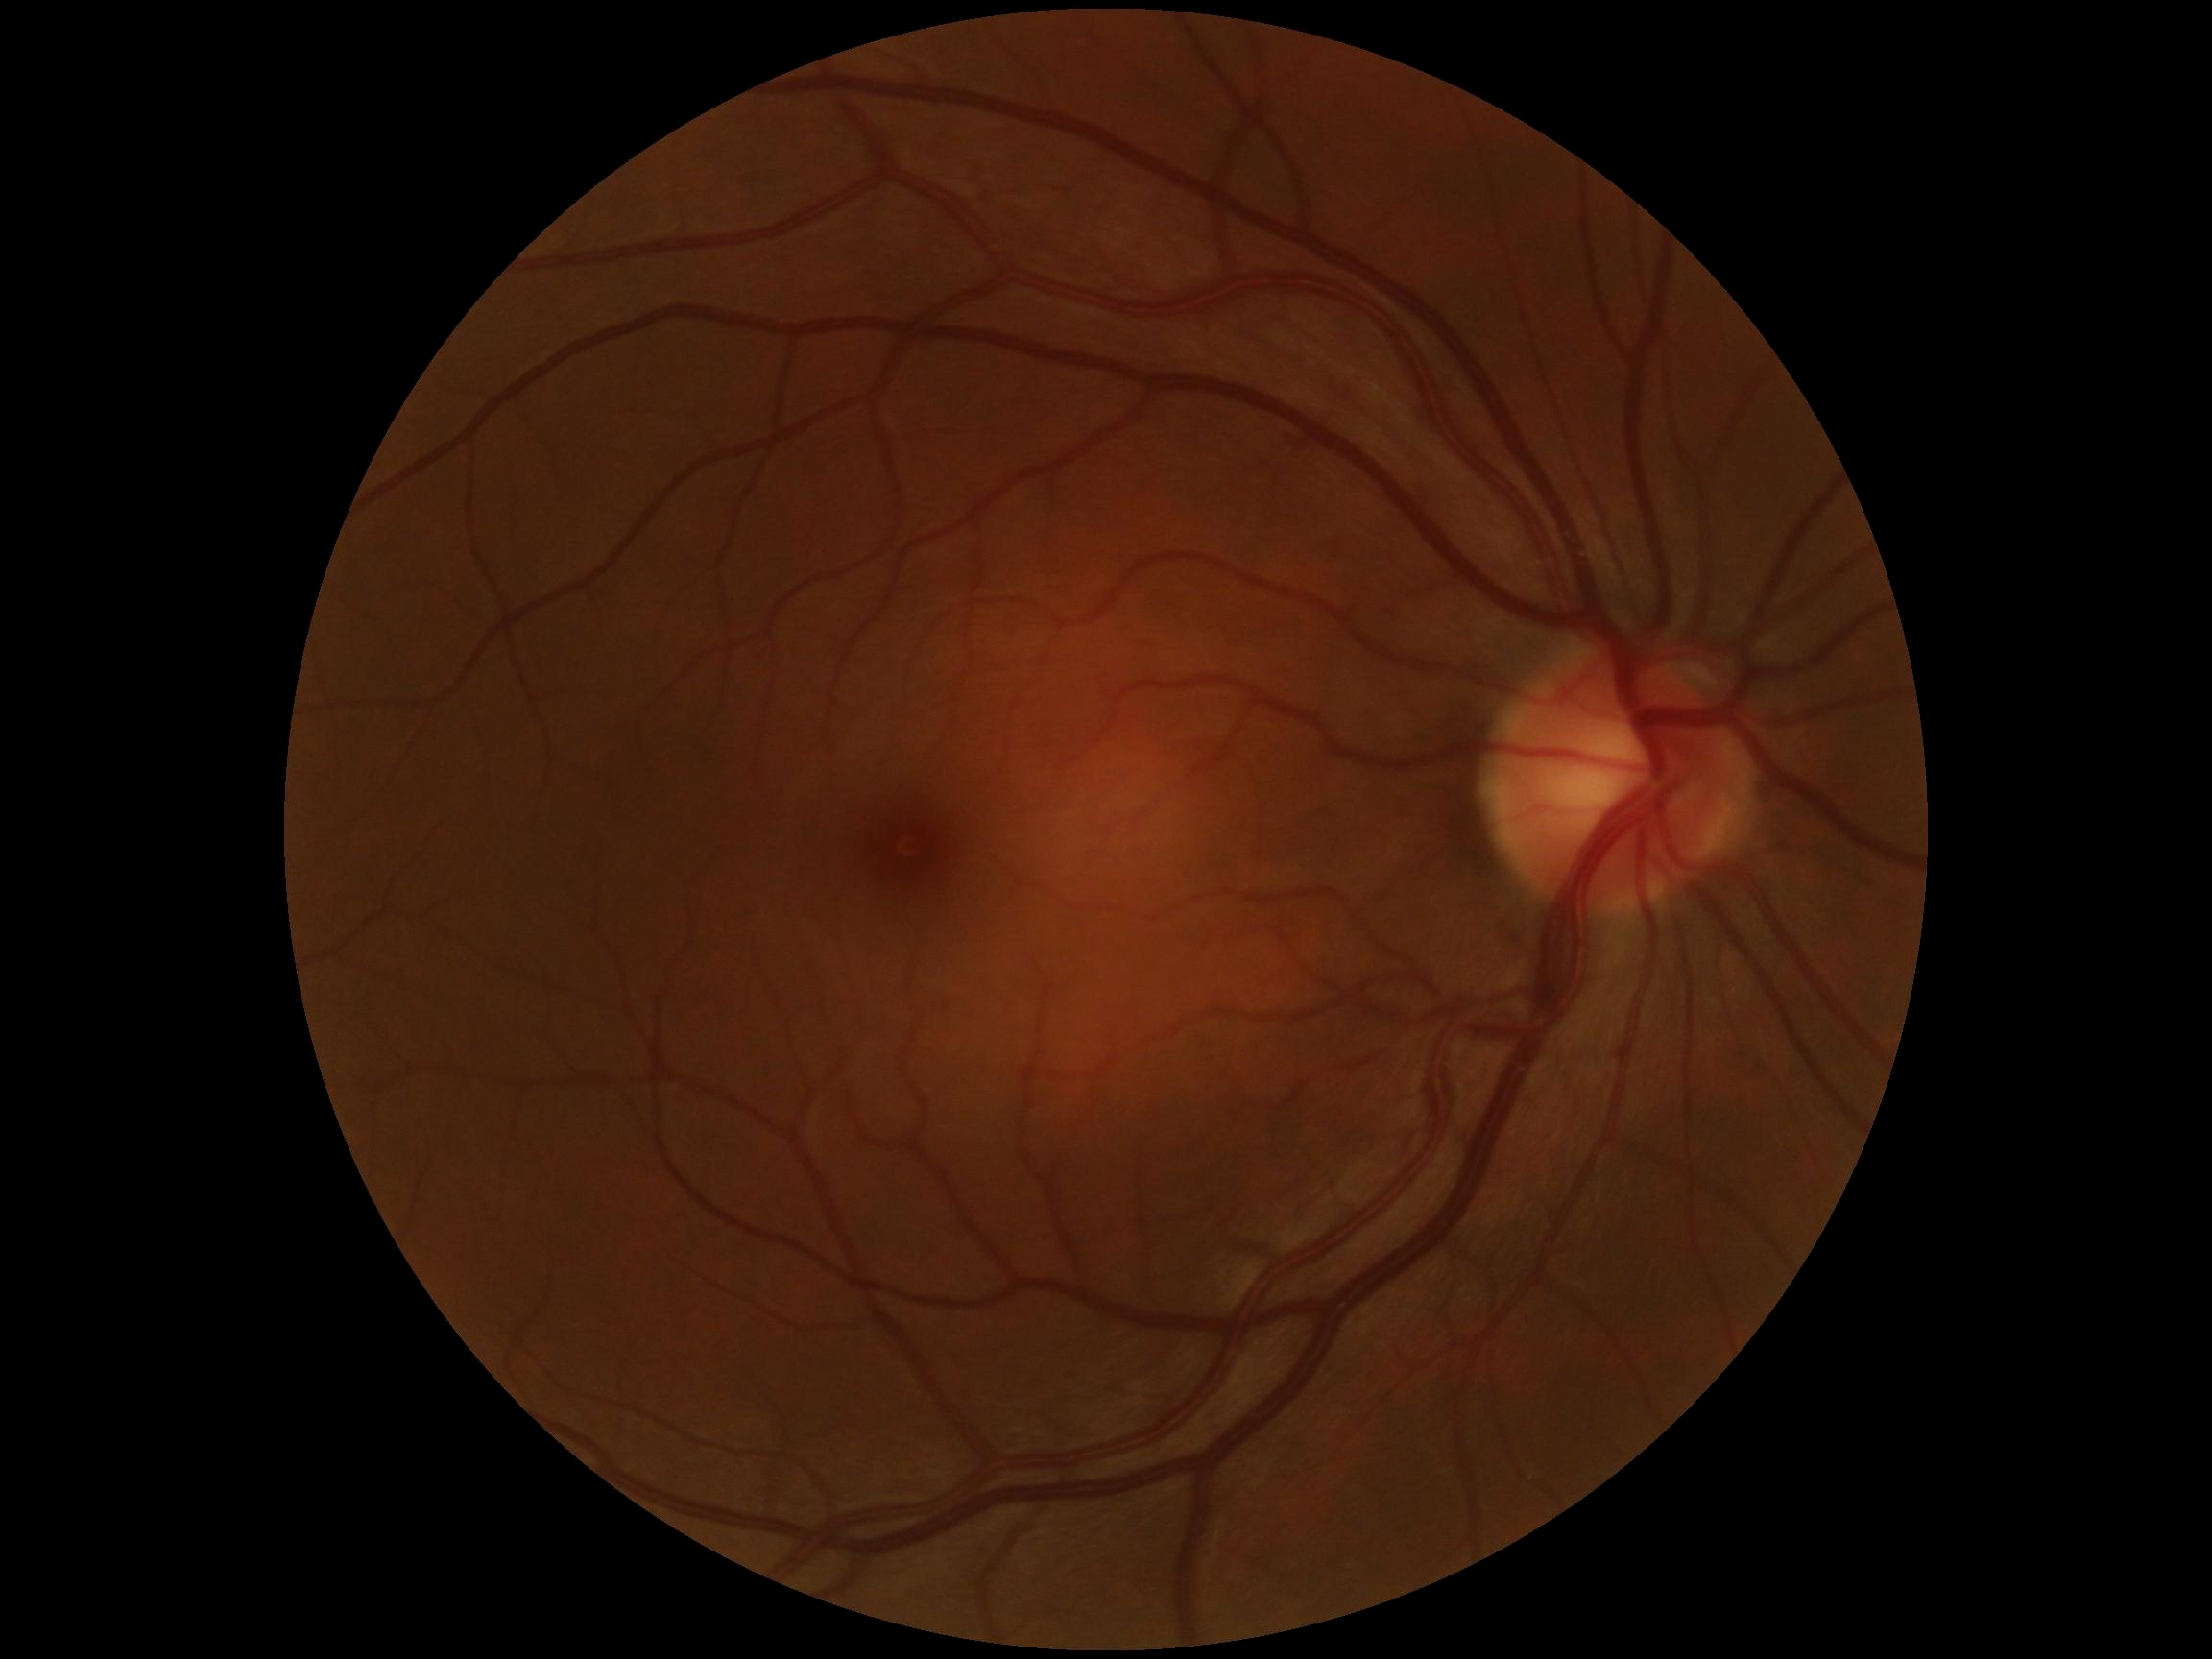

DR: grade 0 (no apparent retinopathy) — no visible signs of diabetic retinopathy.